45° field of view. Color fundus image: 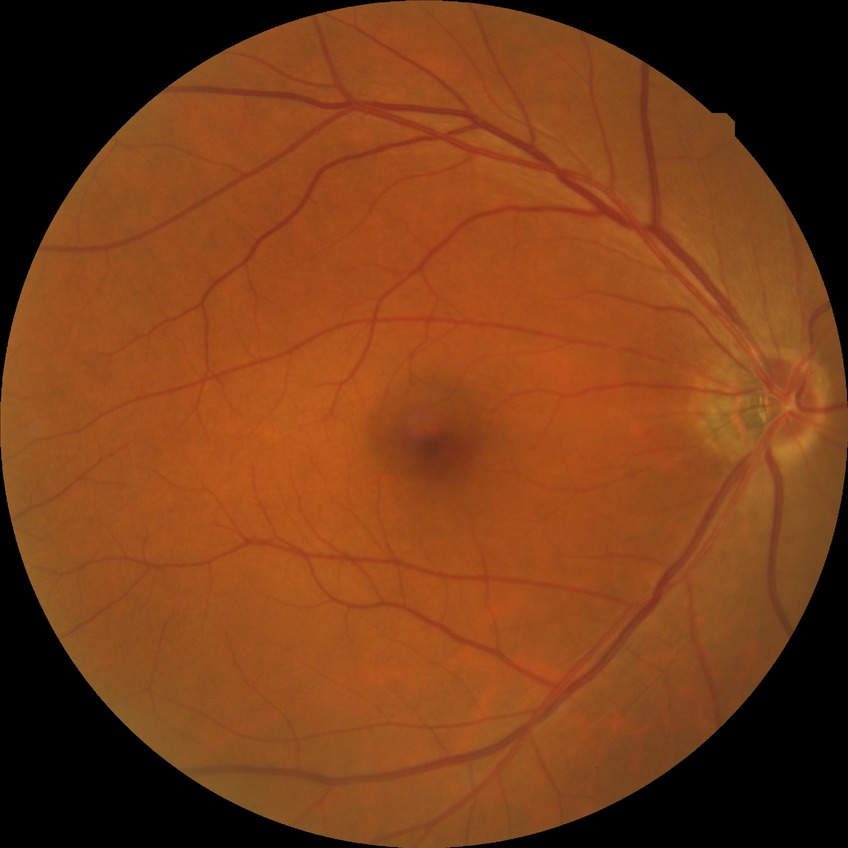
Davis DR grade is NDR.
No apparent diabetic retinopathy.